Non-mydriatic acquisition. Sex: F. Acquired with a Topcon TRC-NW400. Axial length (AL): 22.61 mm. Intraocular pressure 22 mmHg by non-contact tonometry. Disc-centered field. 30° field of view.
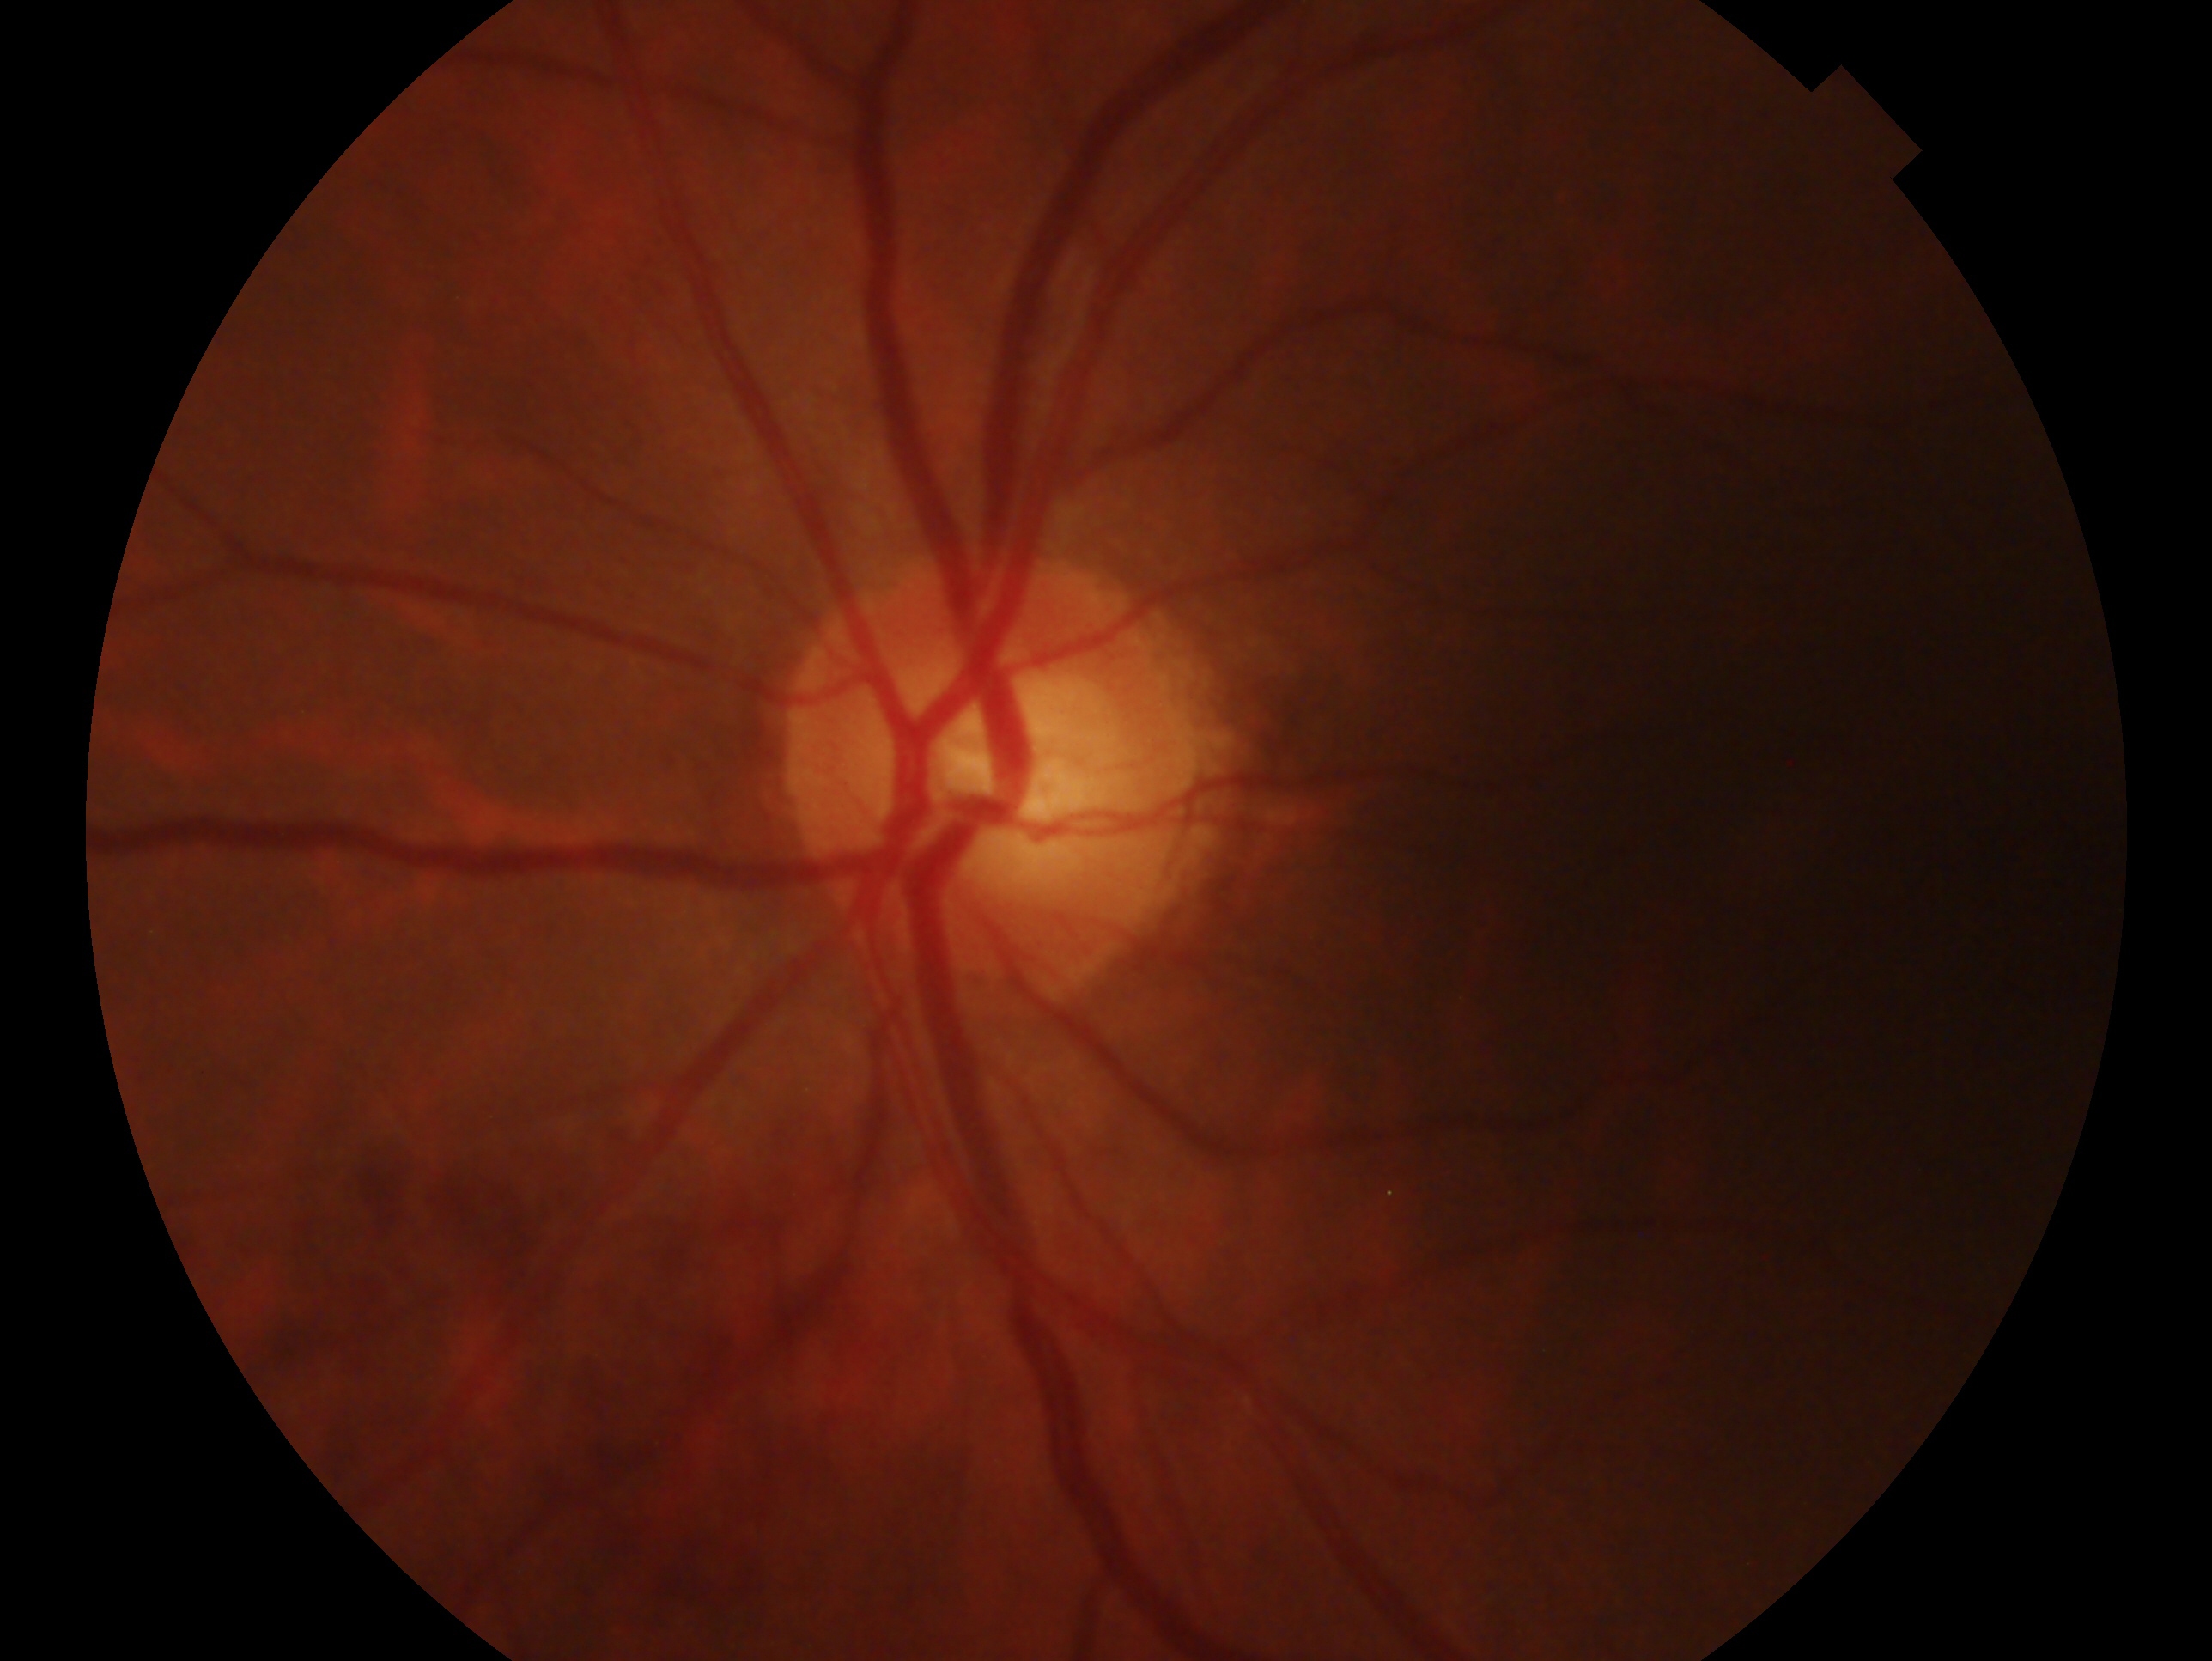
laterality=left eye; assessment=possible glaucoma.